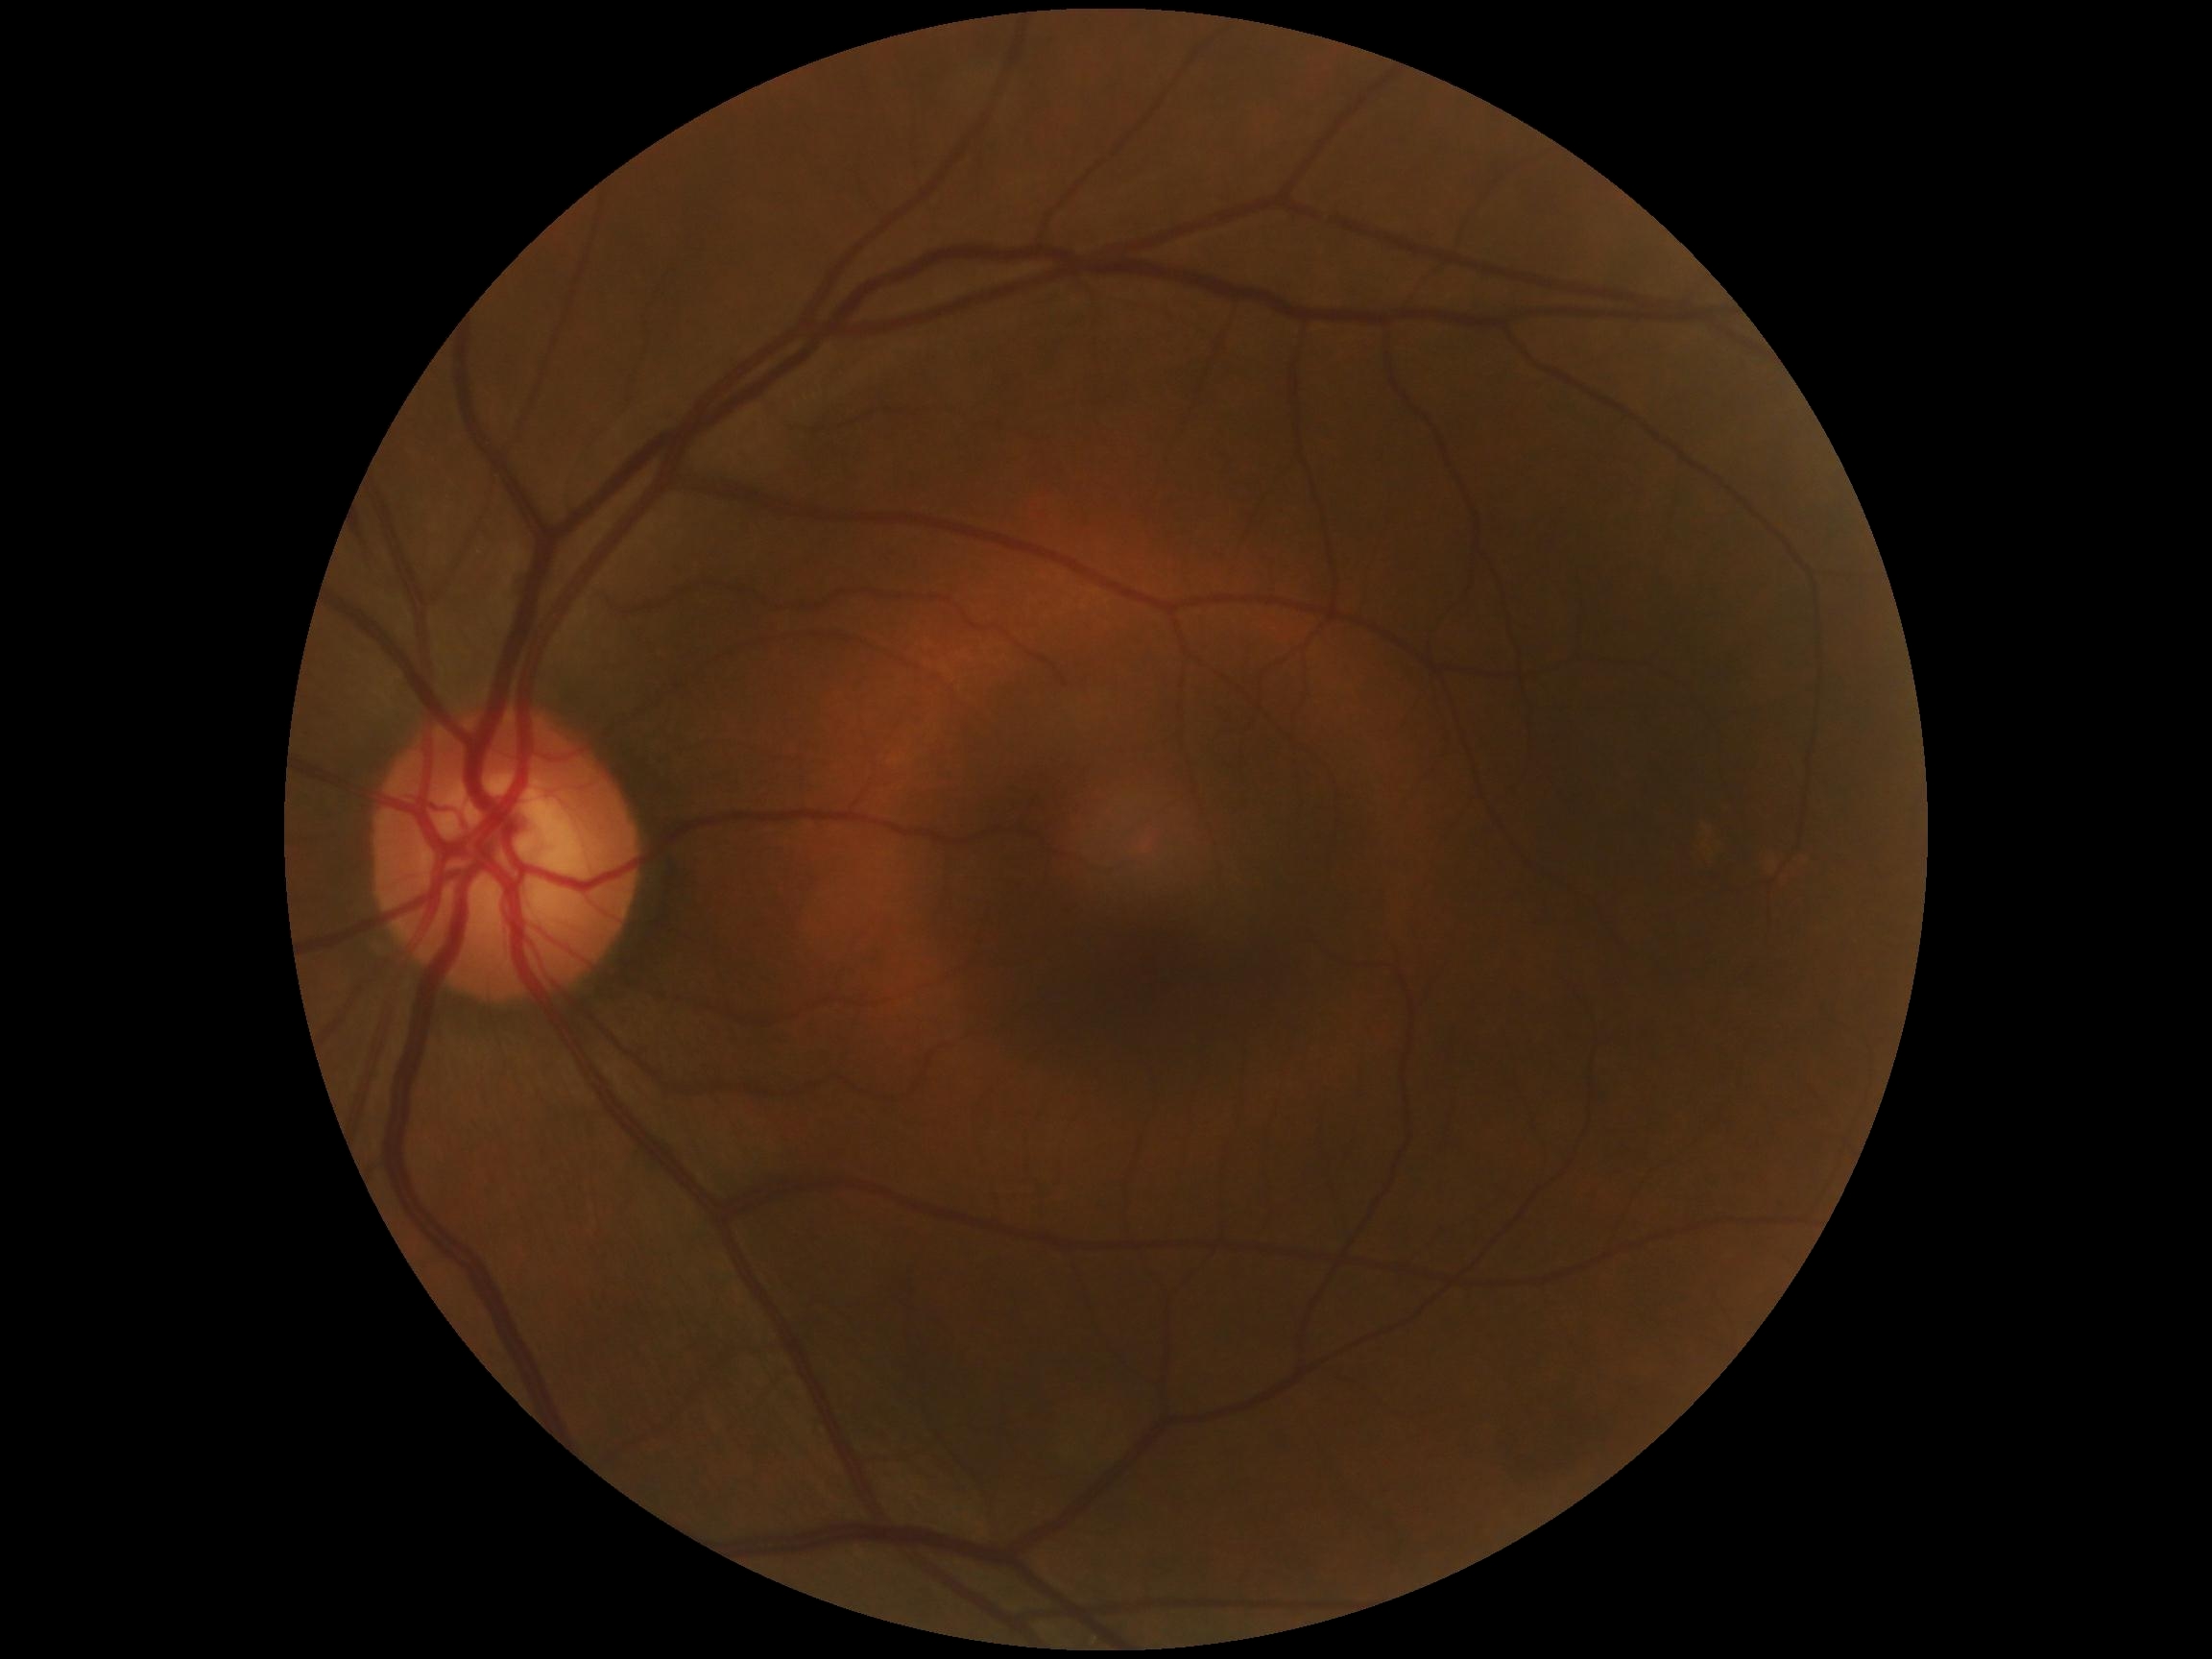
diabetic retinopathy (DR)@grade 0 (no apparent retinopathy) — no visible signs of diabetic retinopathy.